1924x1556. UWF retinal mosaic
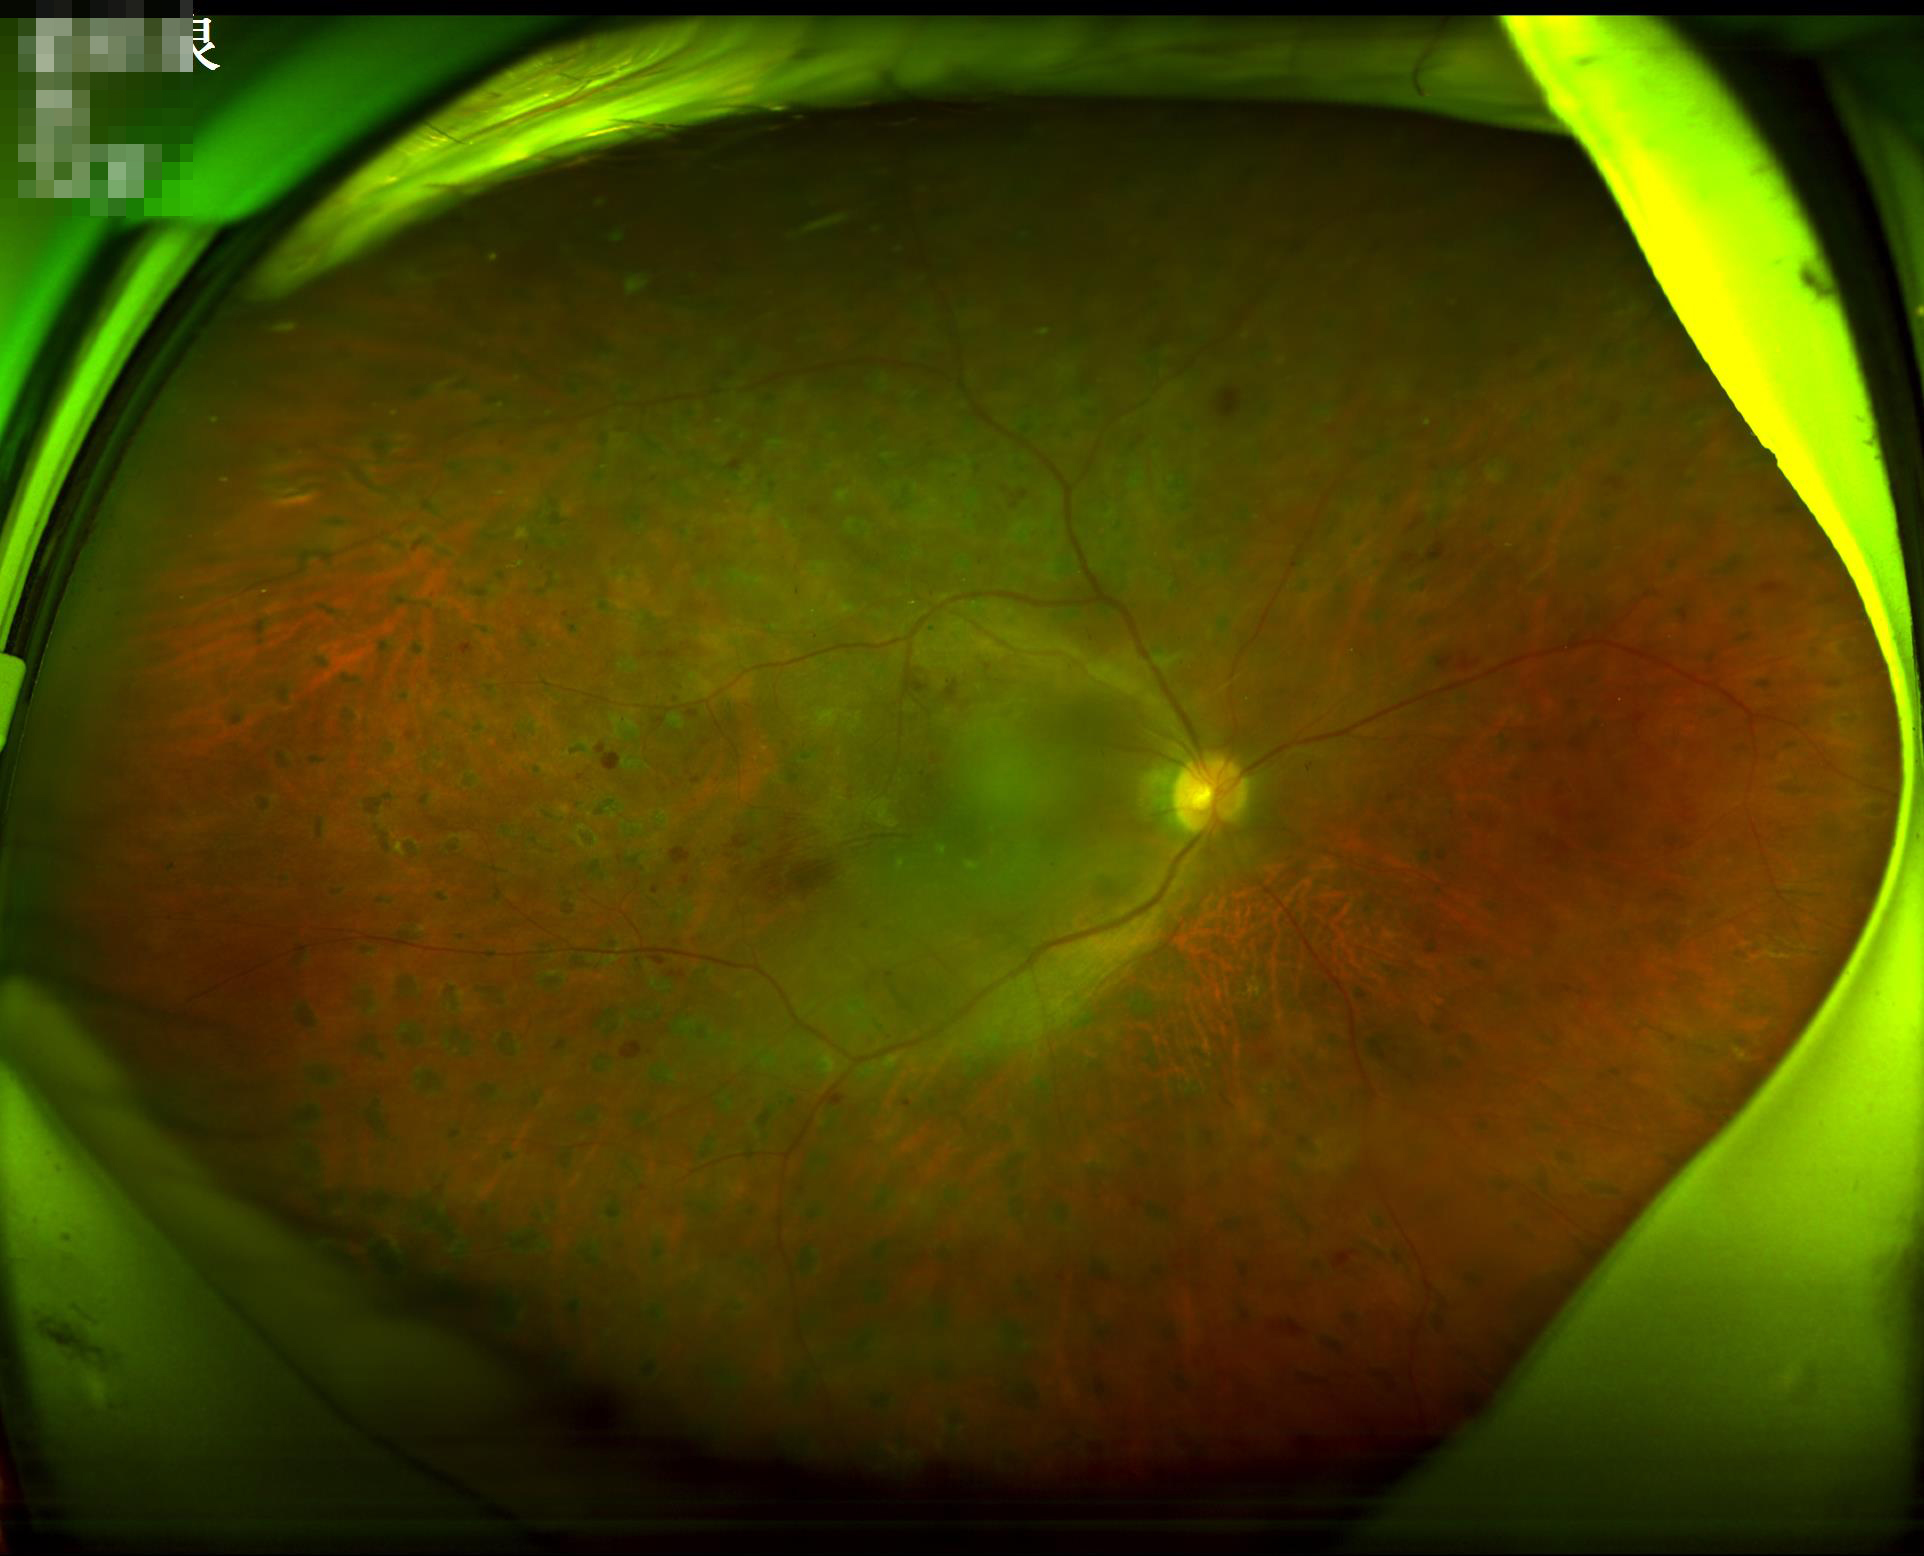
Sharpness: in focus
Contrast: adequate
Illumination/color: adequate
Overall quality: acceptable